Wide-field fundus photograph from neonatal ROP screening: 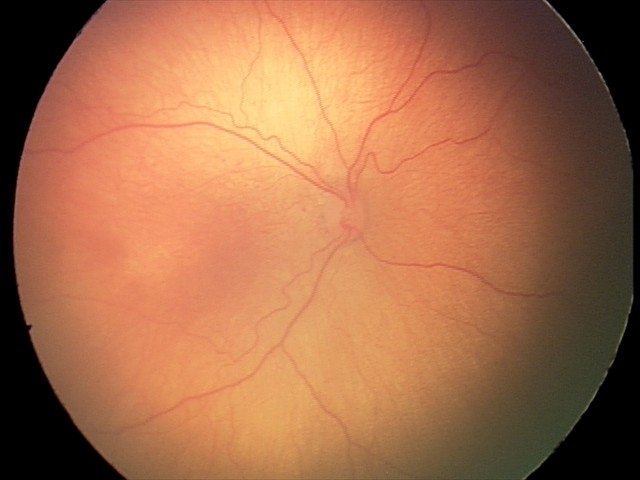 Screening: ROP stage 2 — ridge with height and width at the demarcation line; no plus disease.